1659x2212: 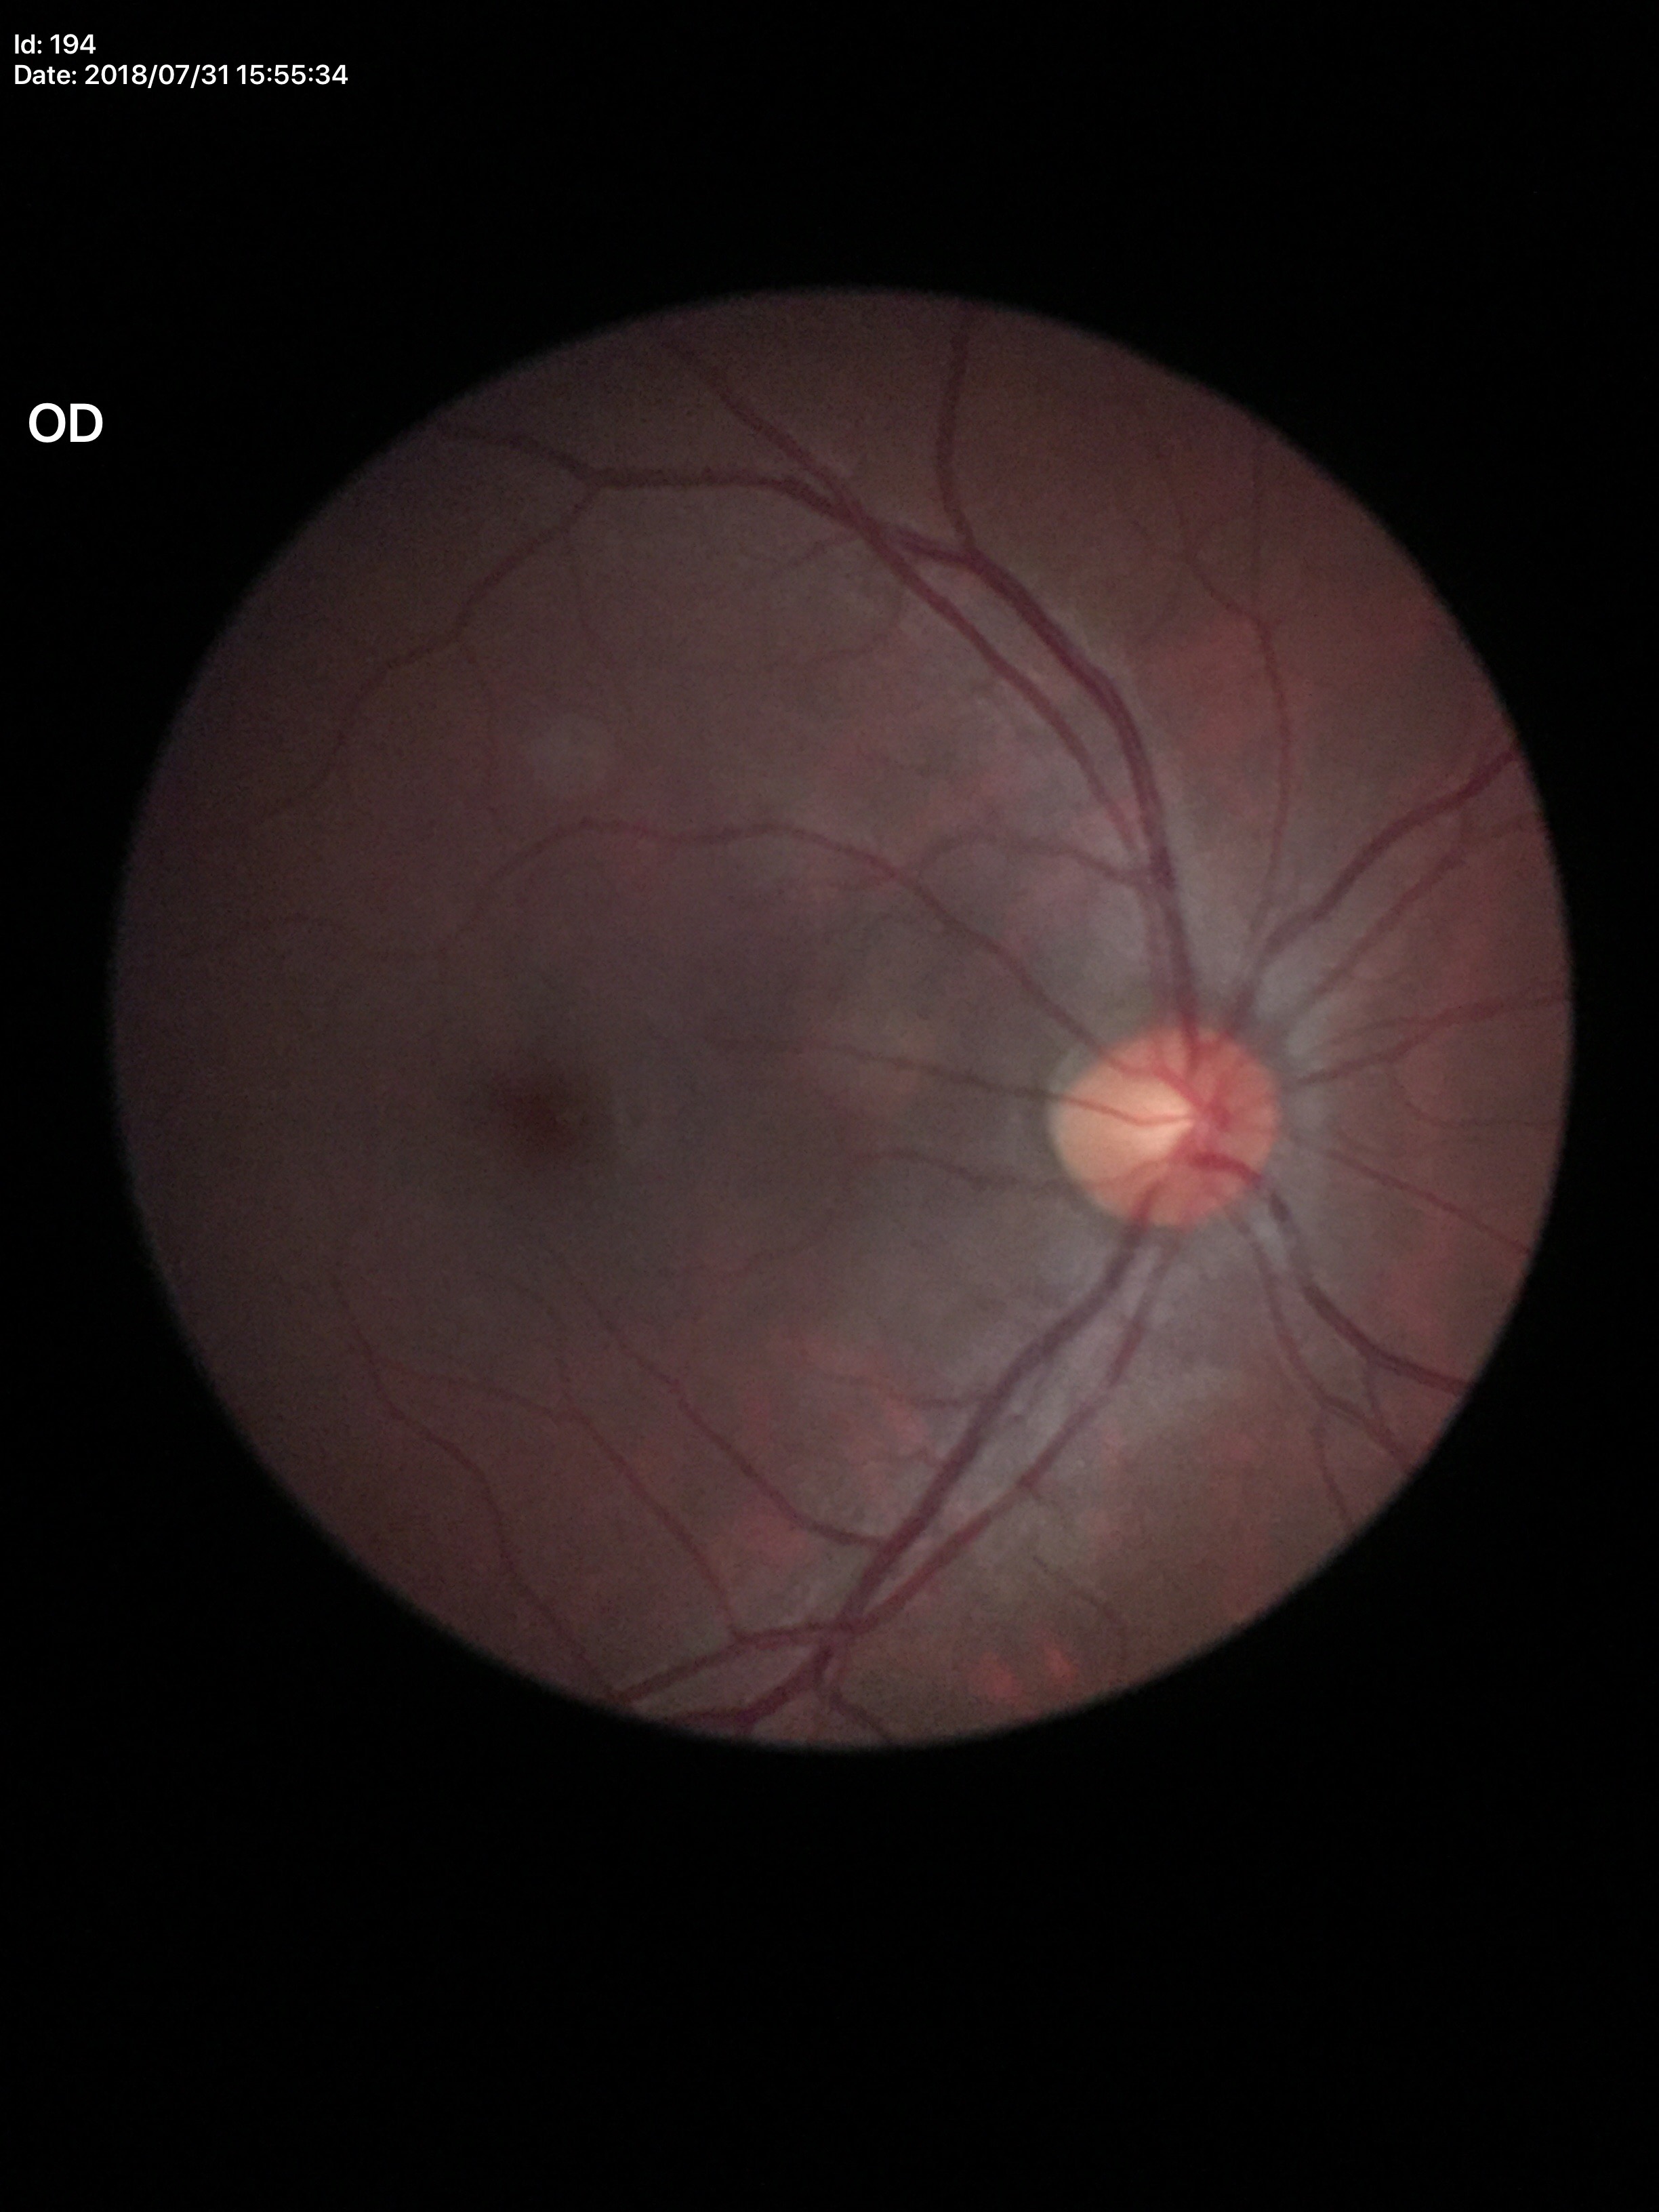
No glaucomatous optic neuropathy. Vertical C/D ratio (VCDR): 0.53.